Camera: NIDEK AFC-230; color fundus photograph; 848 x 848 pixels; graded on the modified Davis scale; 45° FOV; no pharmacologic dilation: 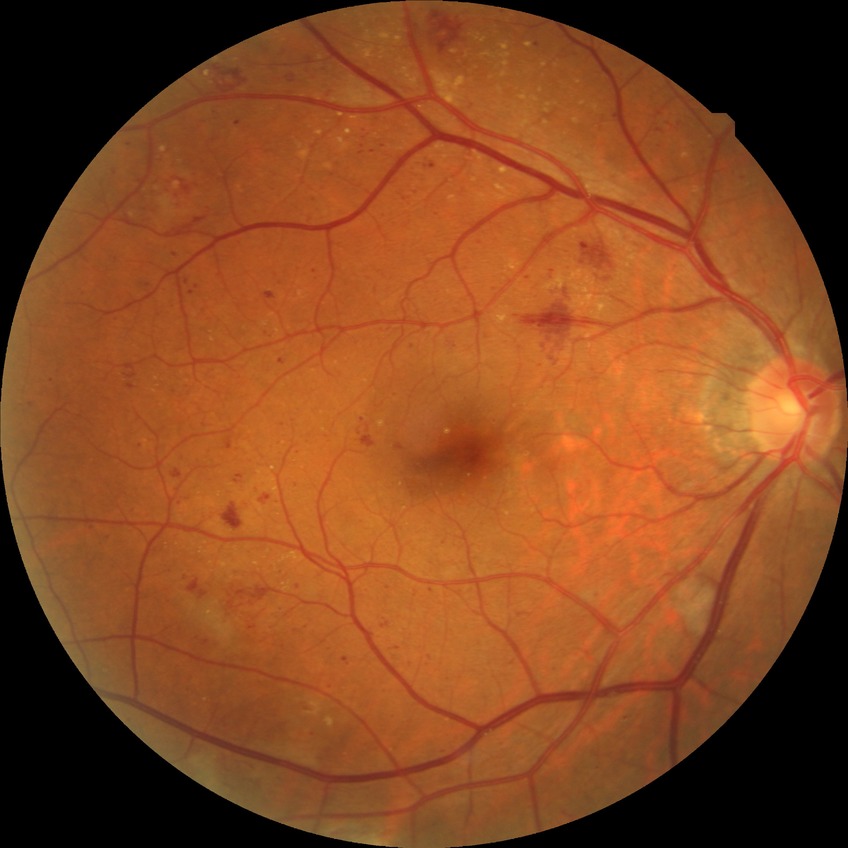

DR class: non-proliferative diabetic retinopathy.
Retinopathy grade: pre-proliferative diabetic retinopathy.